1932x1932px — 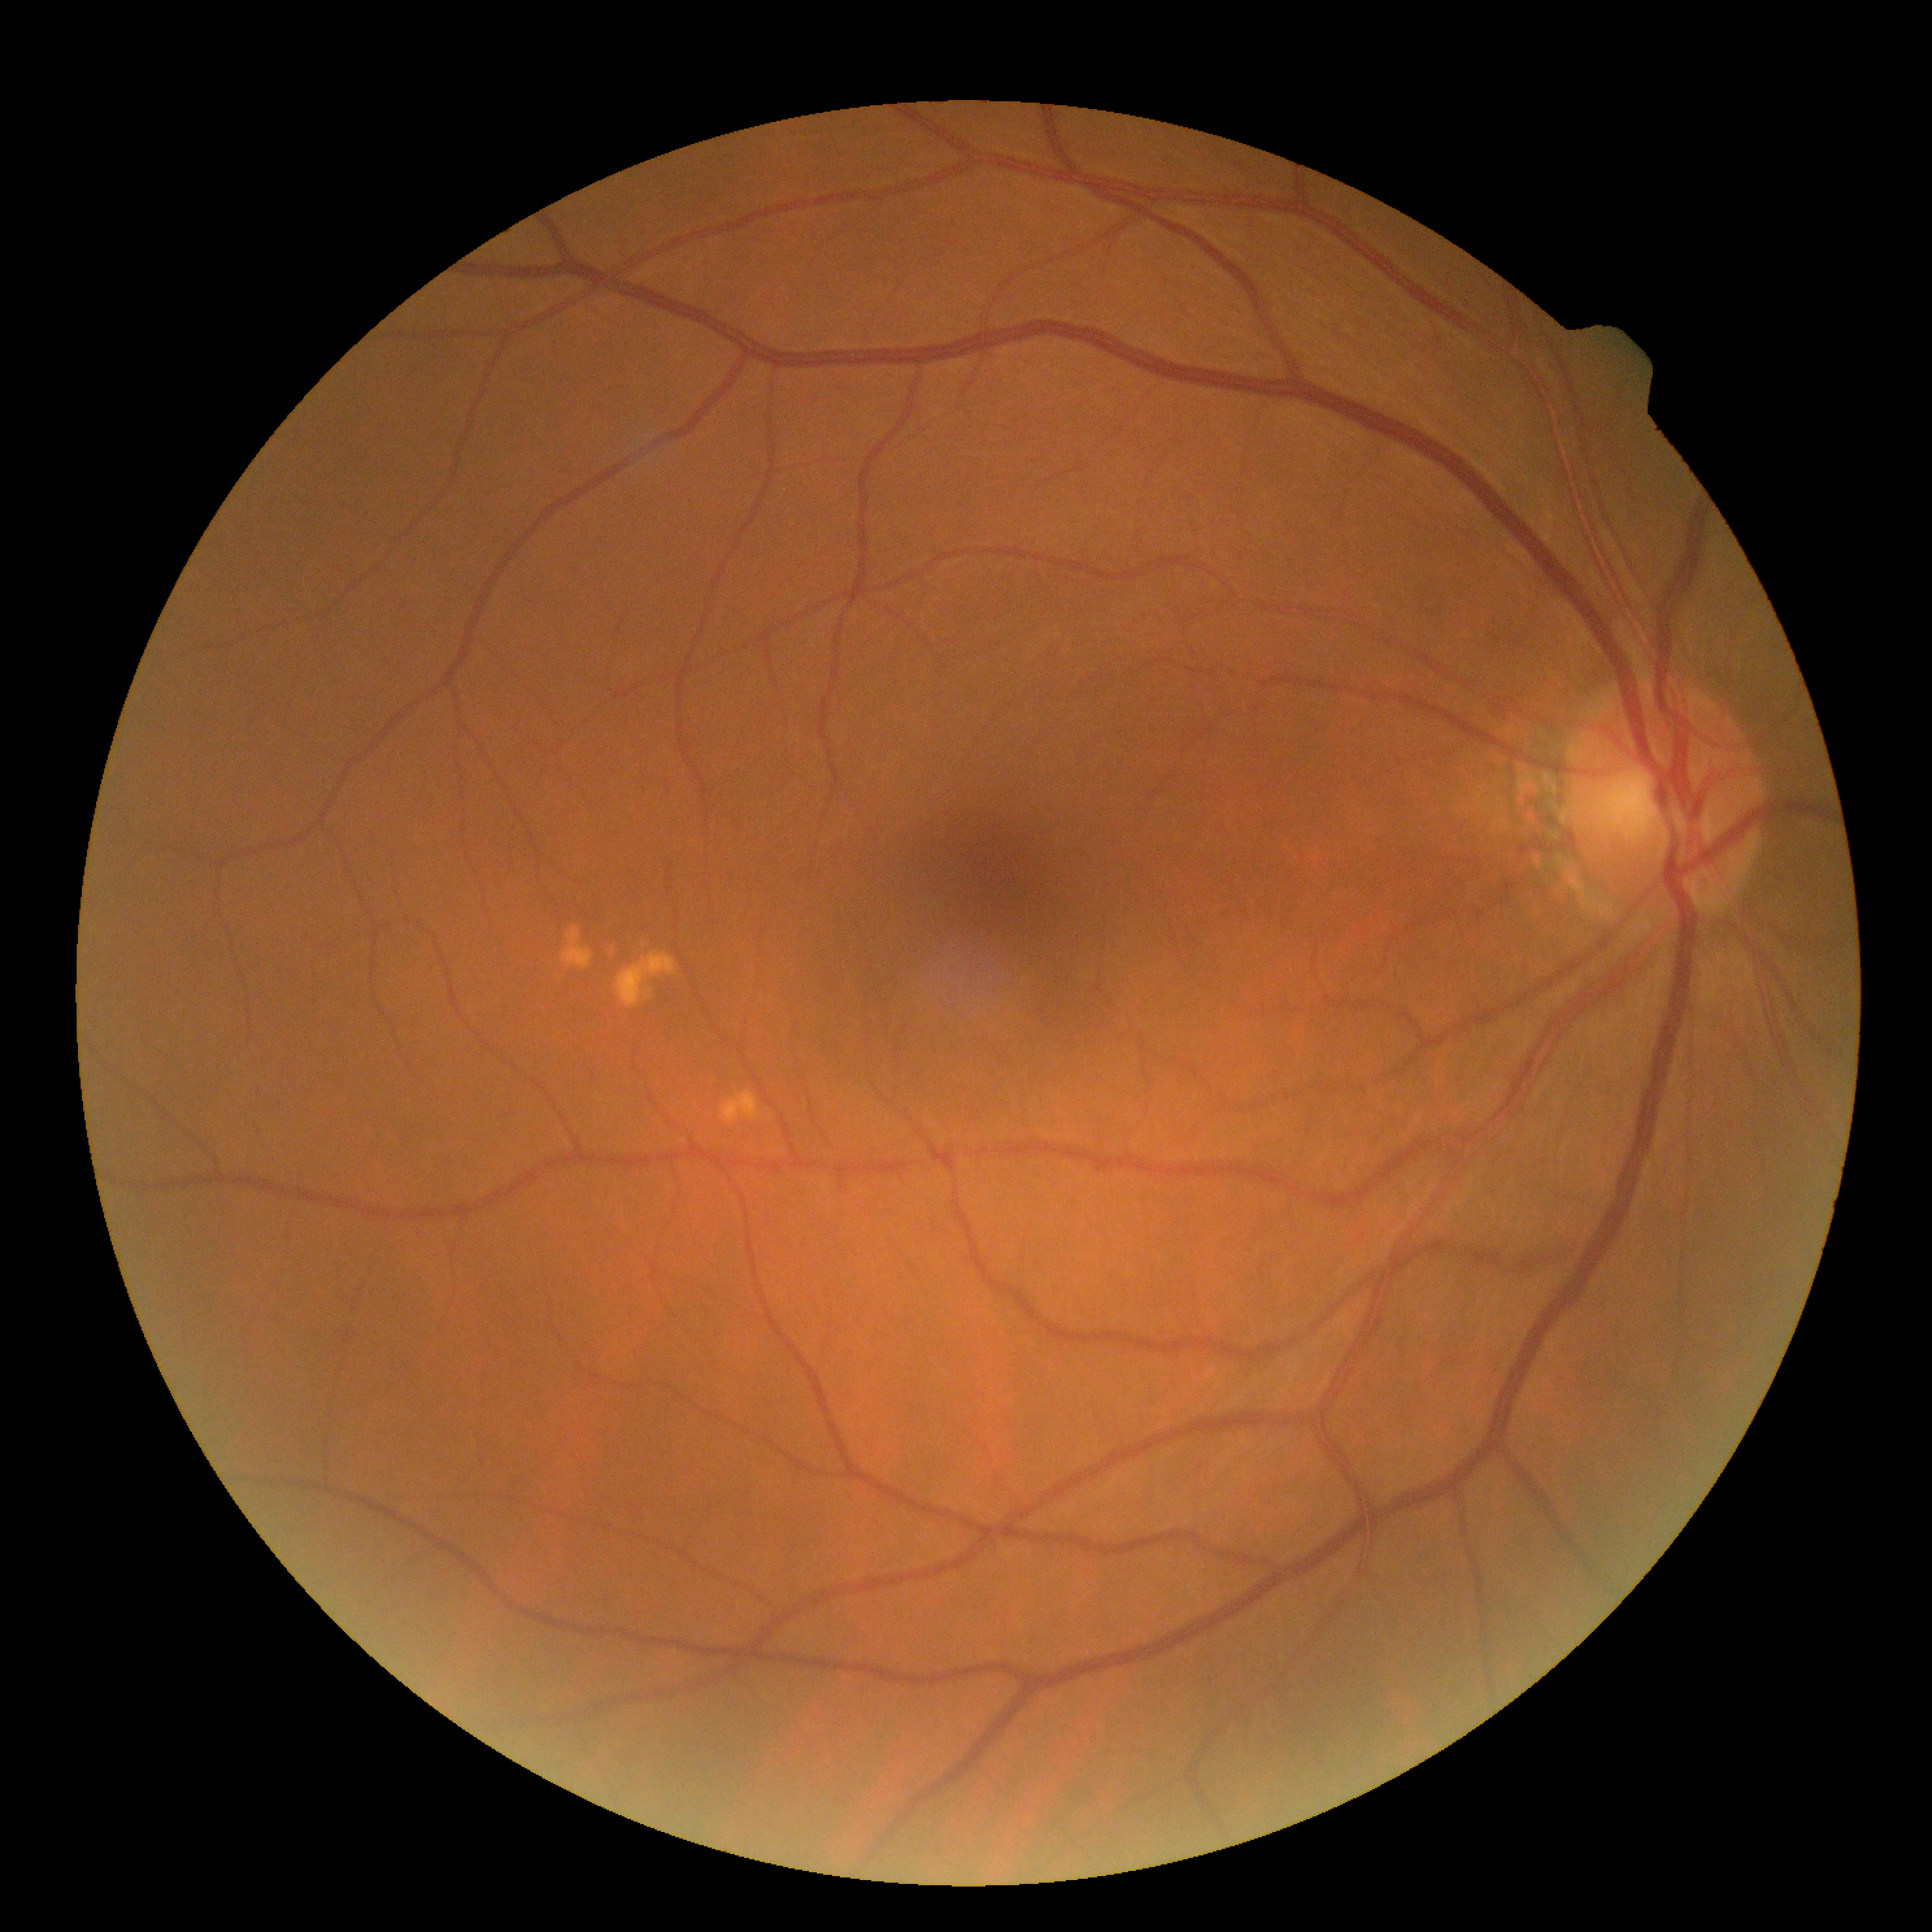 Findings:
– diabetic retinopathy: no apparent diabetic retinopathy (grade 0)
– DR impression: no signs of DR